45° FOV · 2352x1568px — 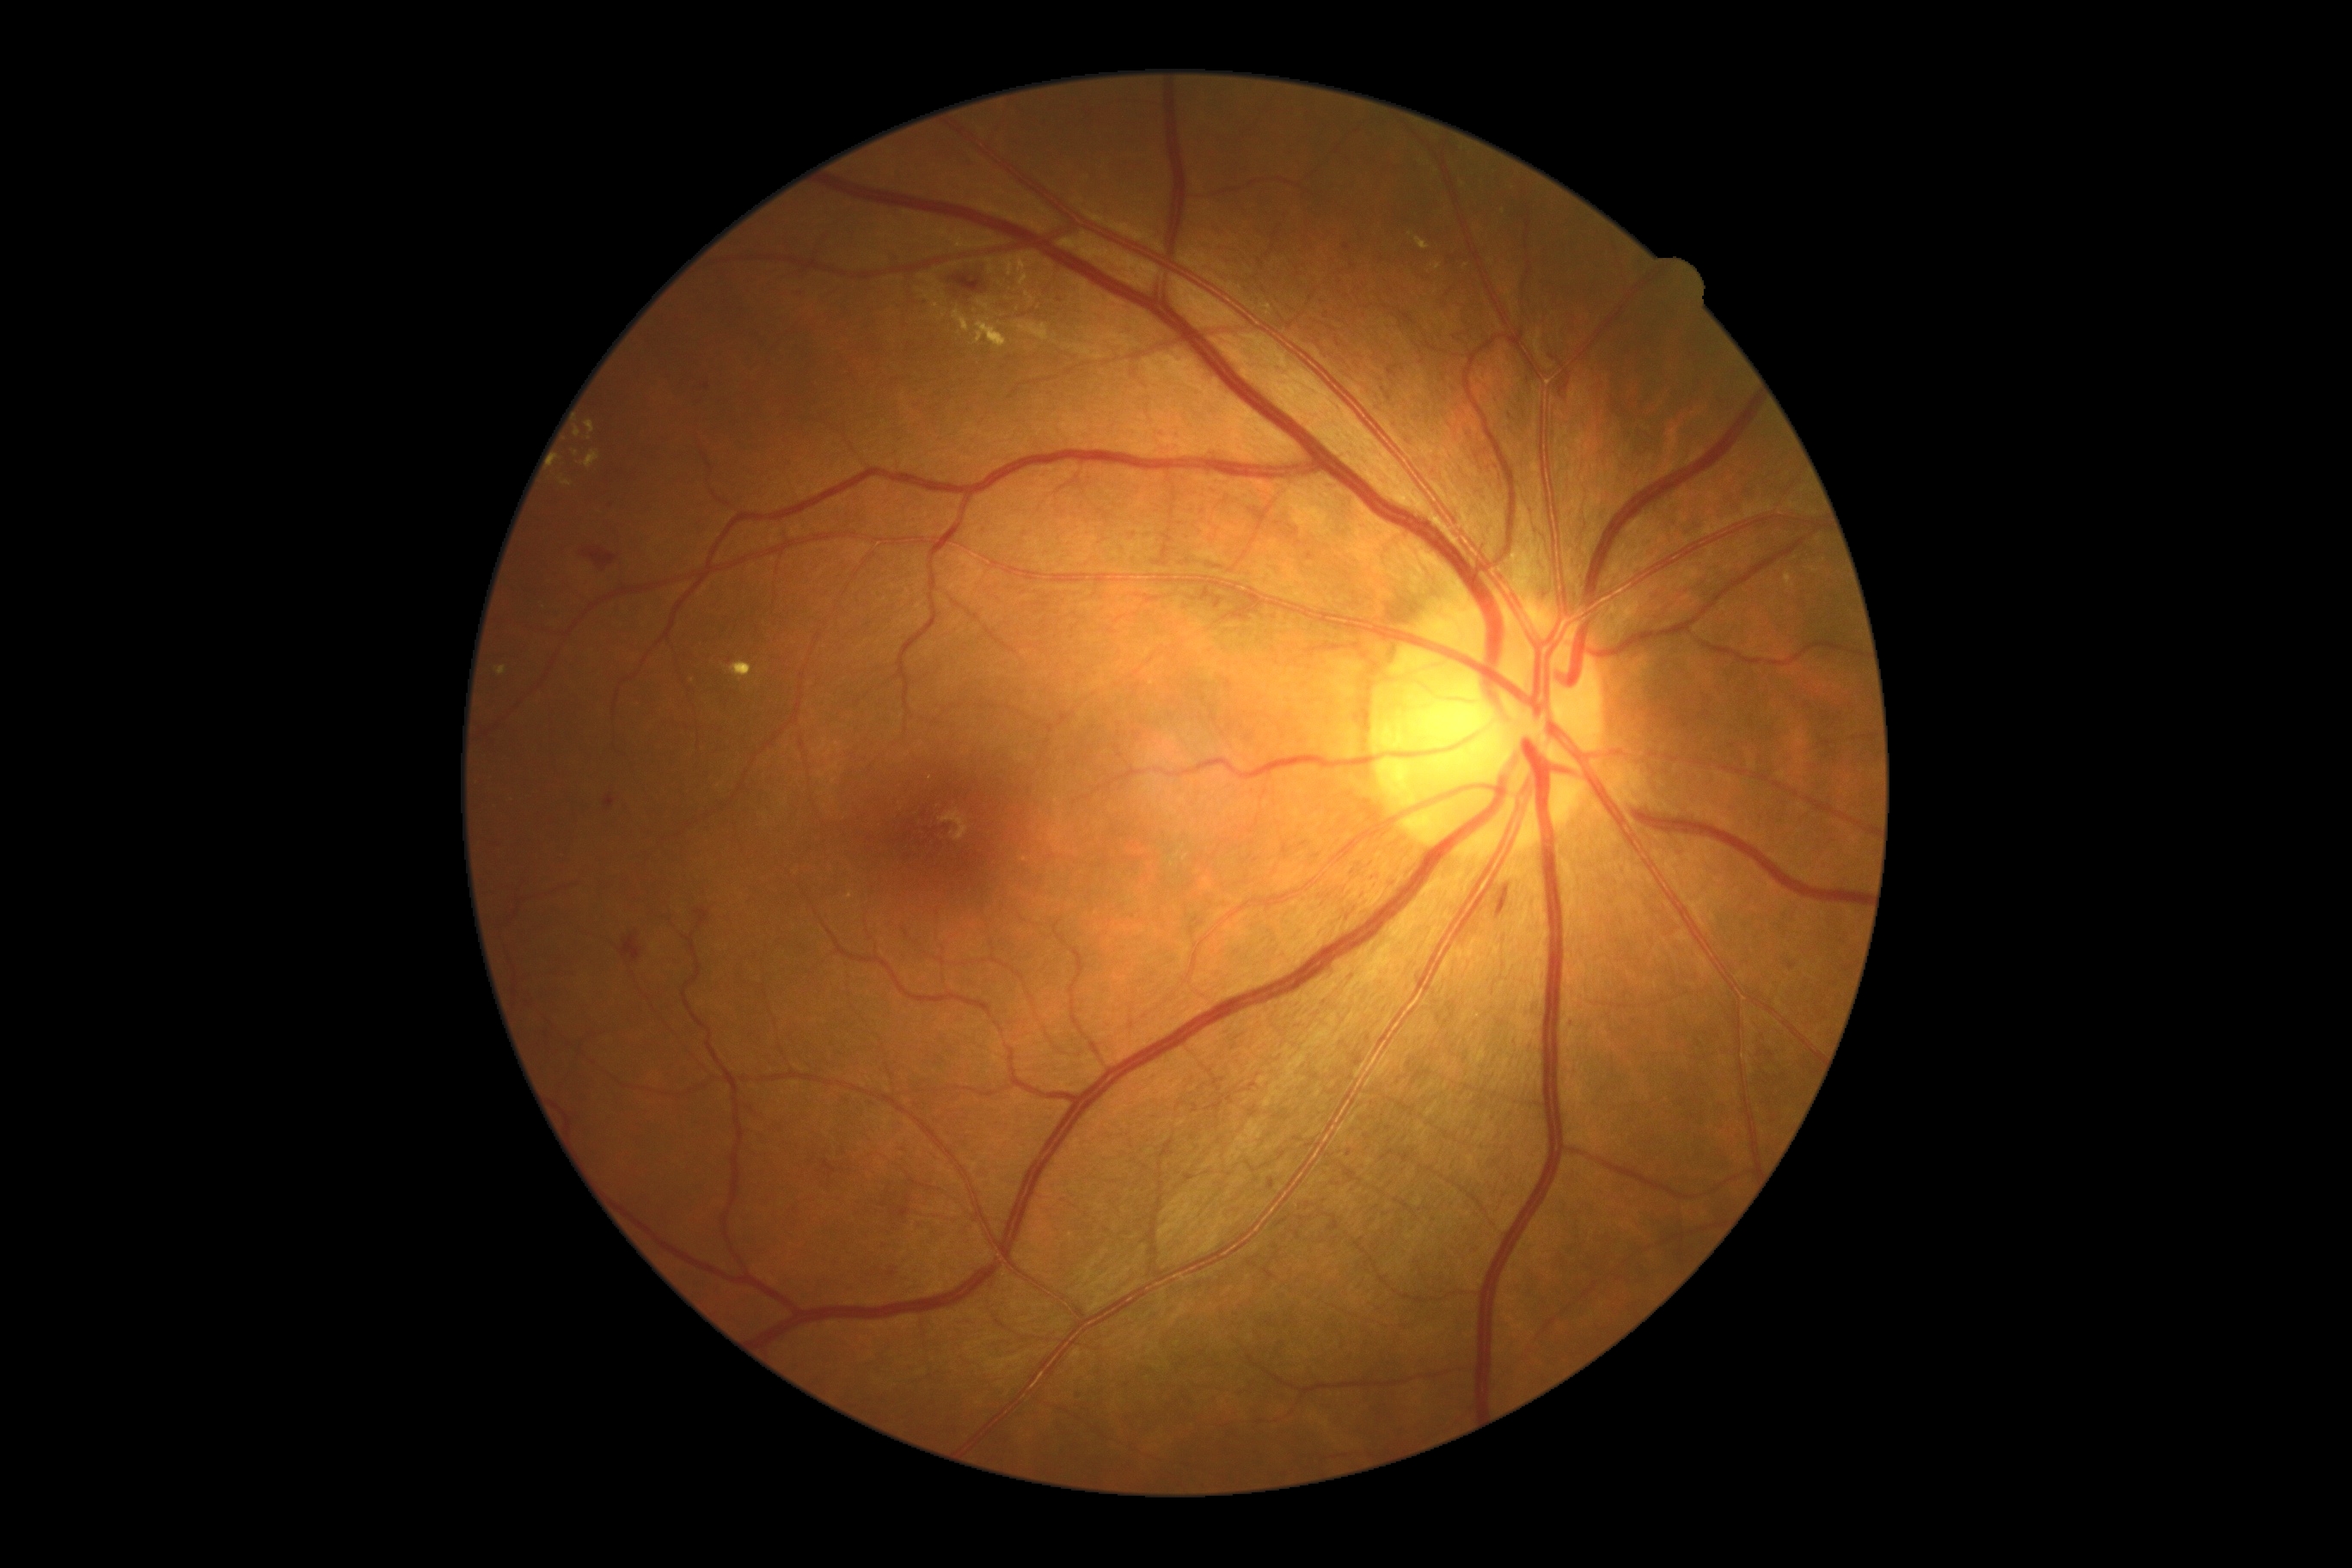

Diabetic retinopathy severity is grade 3.